Posterior pole photograph, 45° field of view: 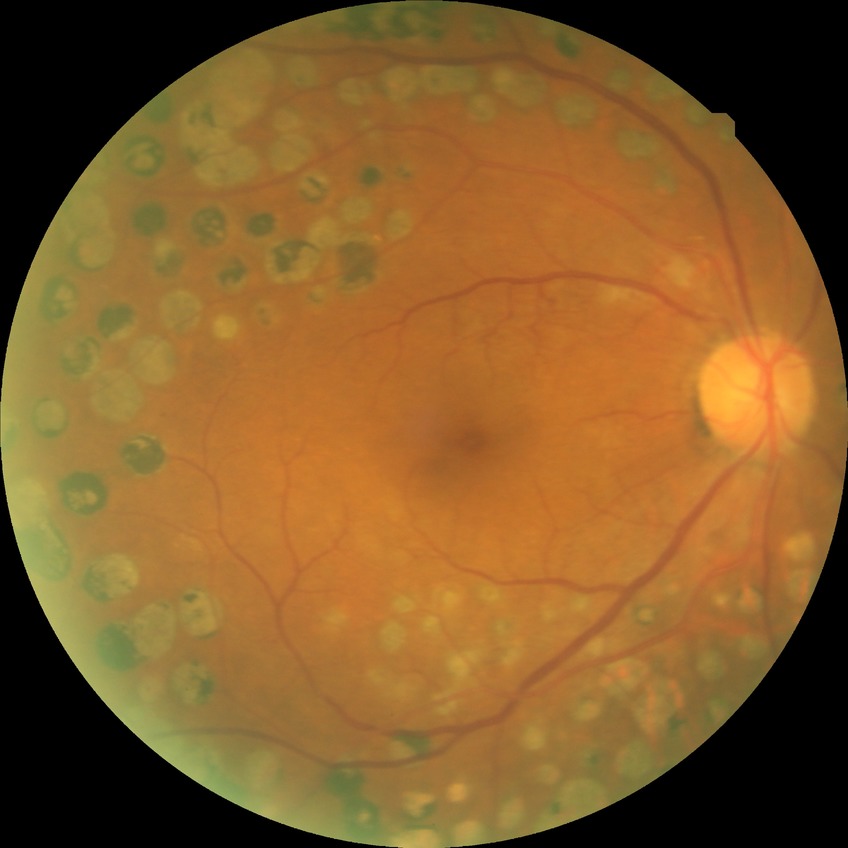
Diabetic retinopathy stage is proliferative diabetic retinopathy.